Without pupil dilation.
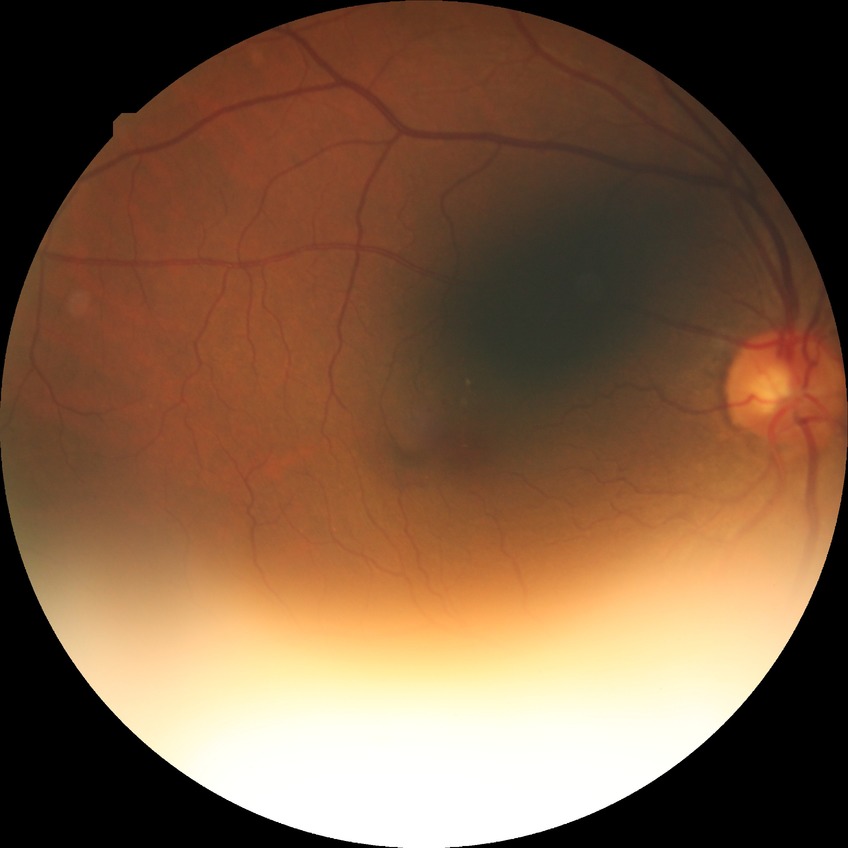

Diabetic retinopathy (DR): NDR (no diabetic retinopathy).